Wide-field contact fundus photograph of an infant · 1240x1240.
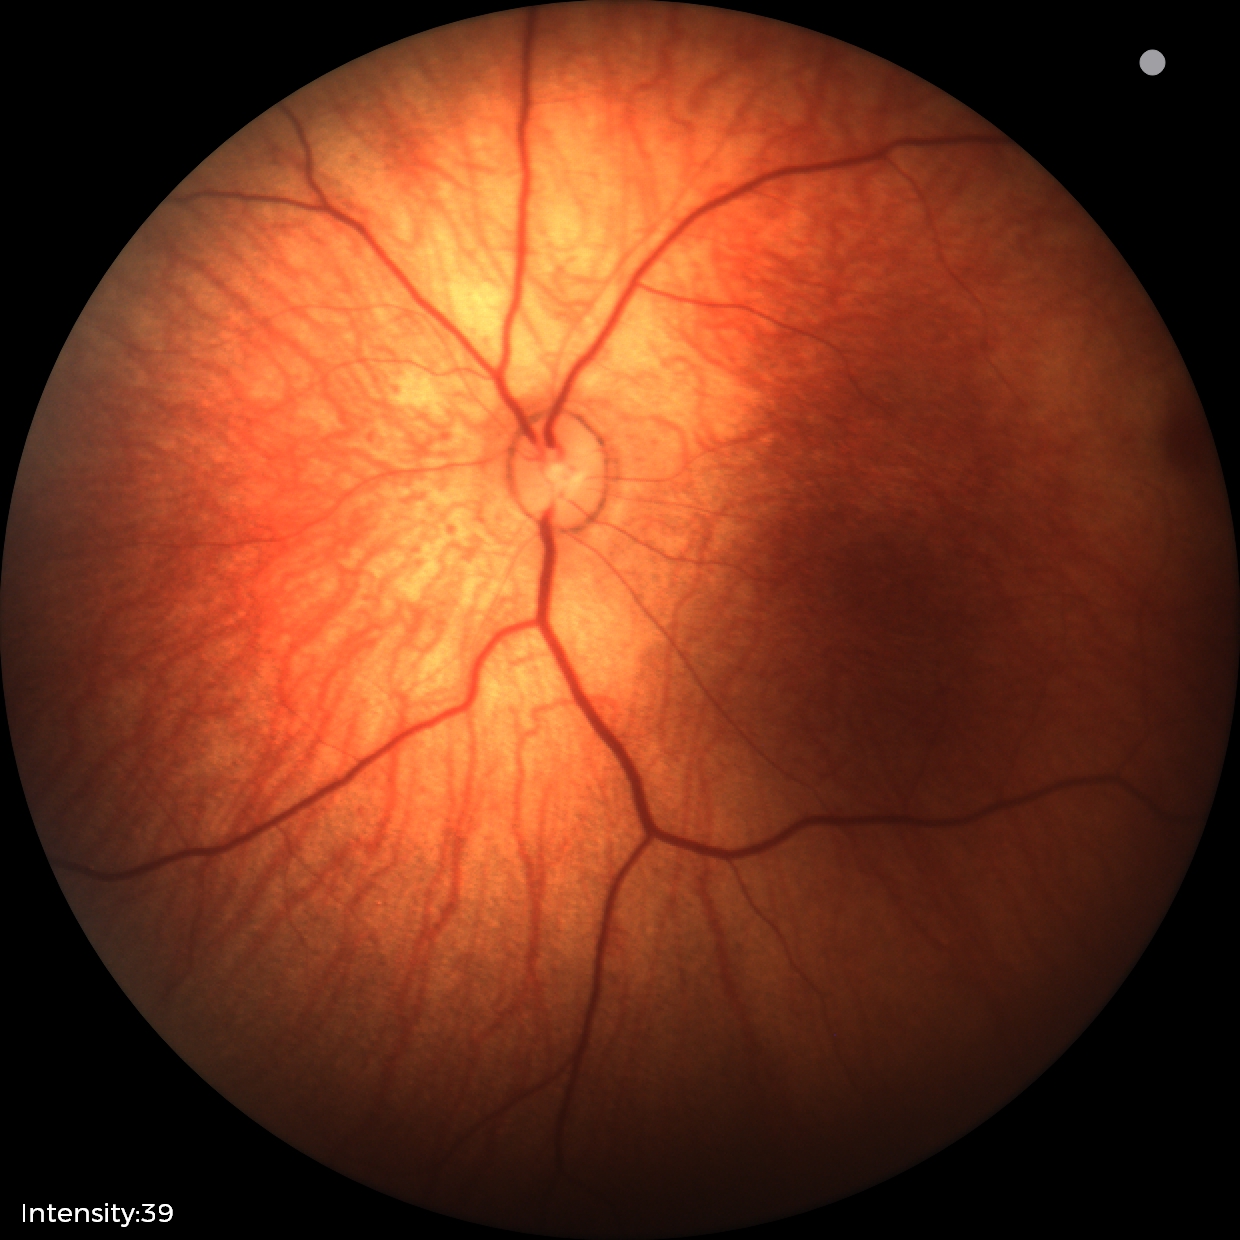
Normal screening examination.